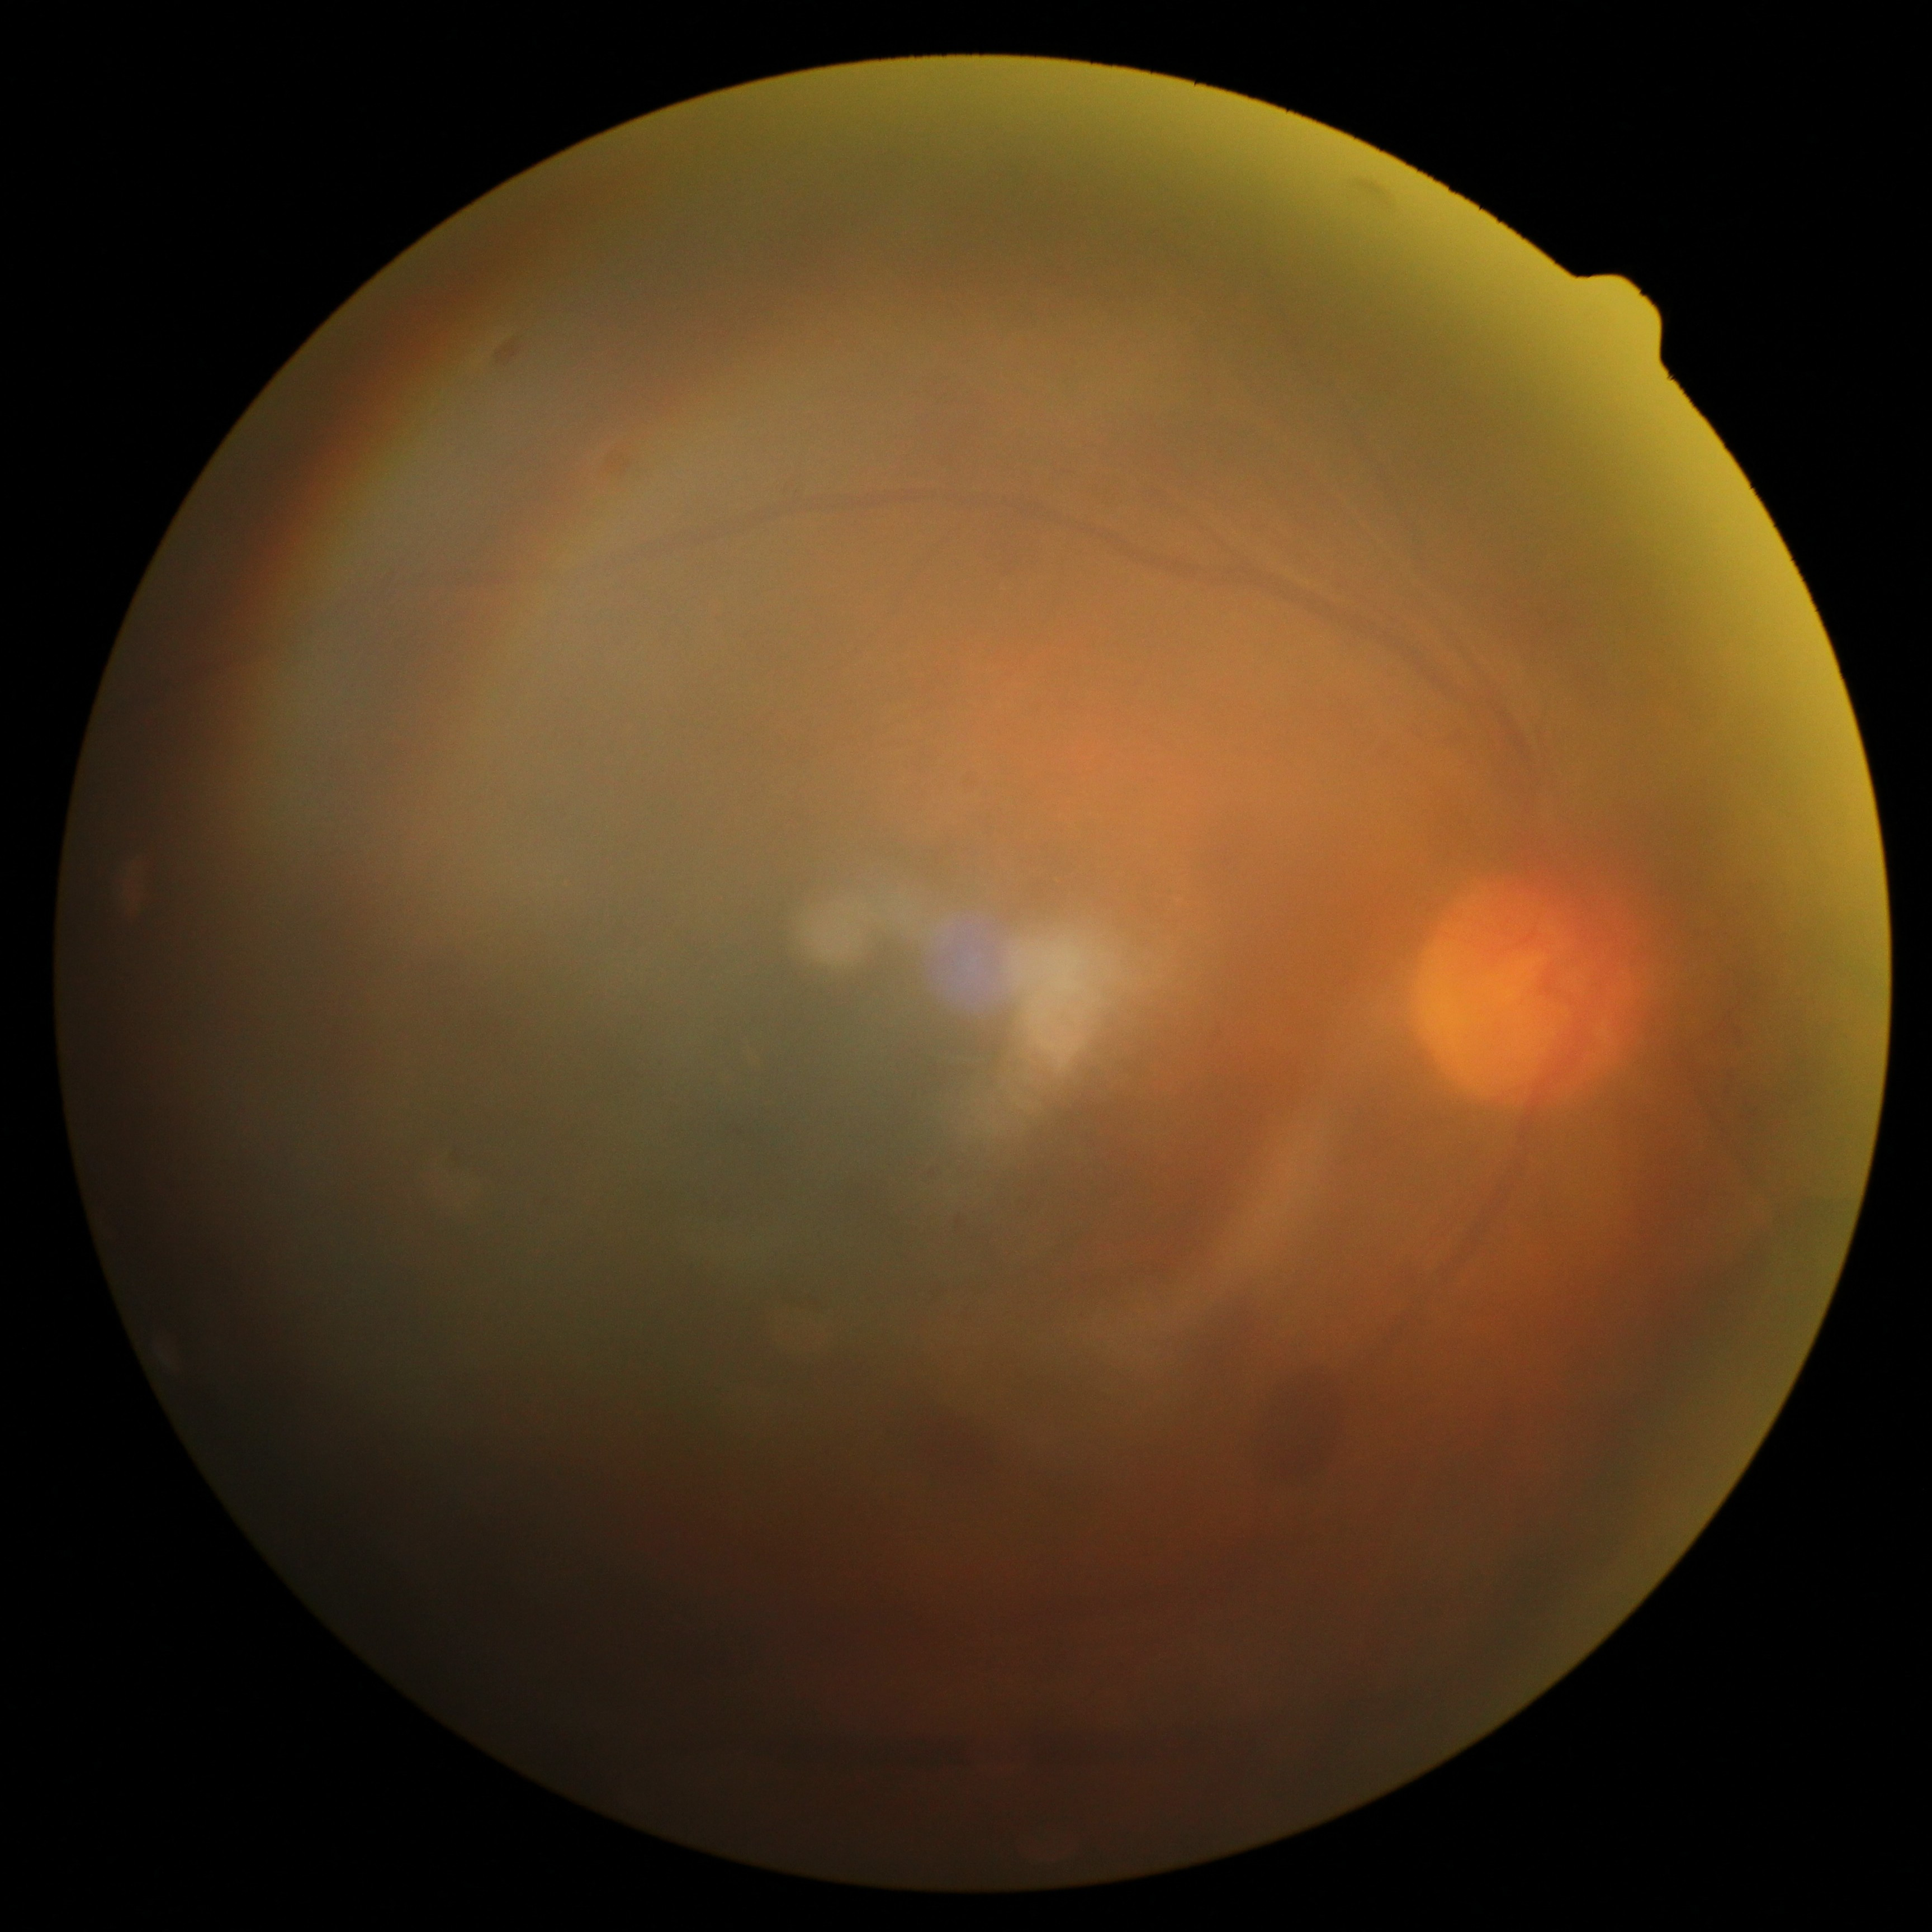

Diabetic retinopathy (DR) is grade 4.